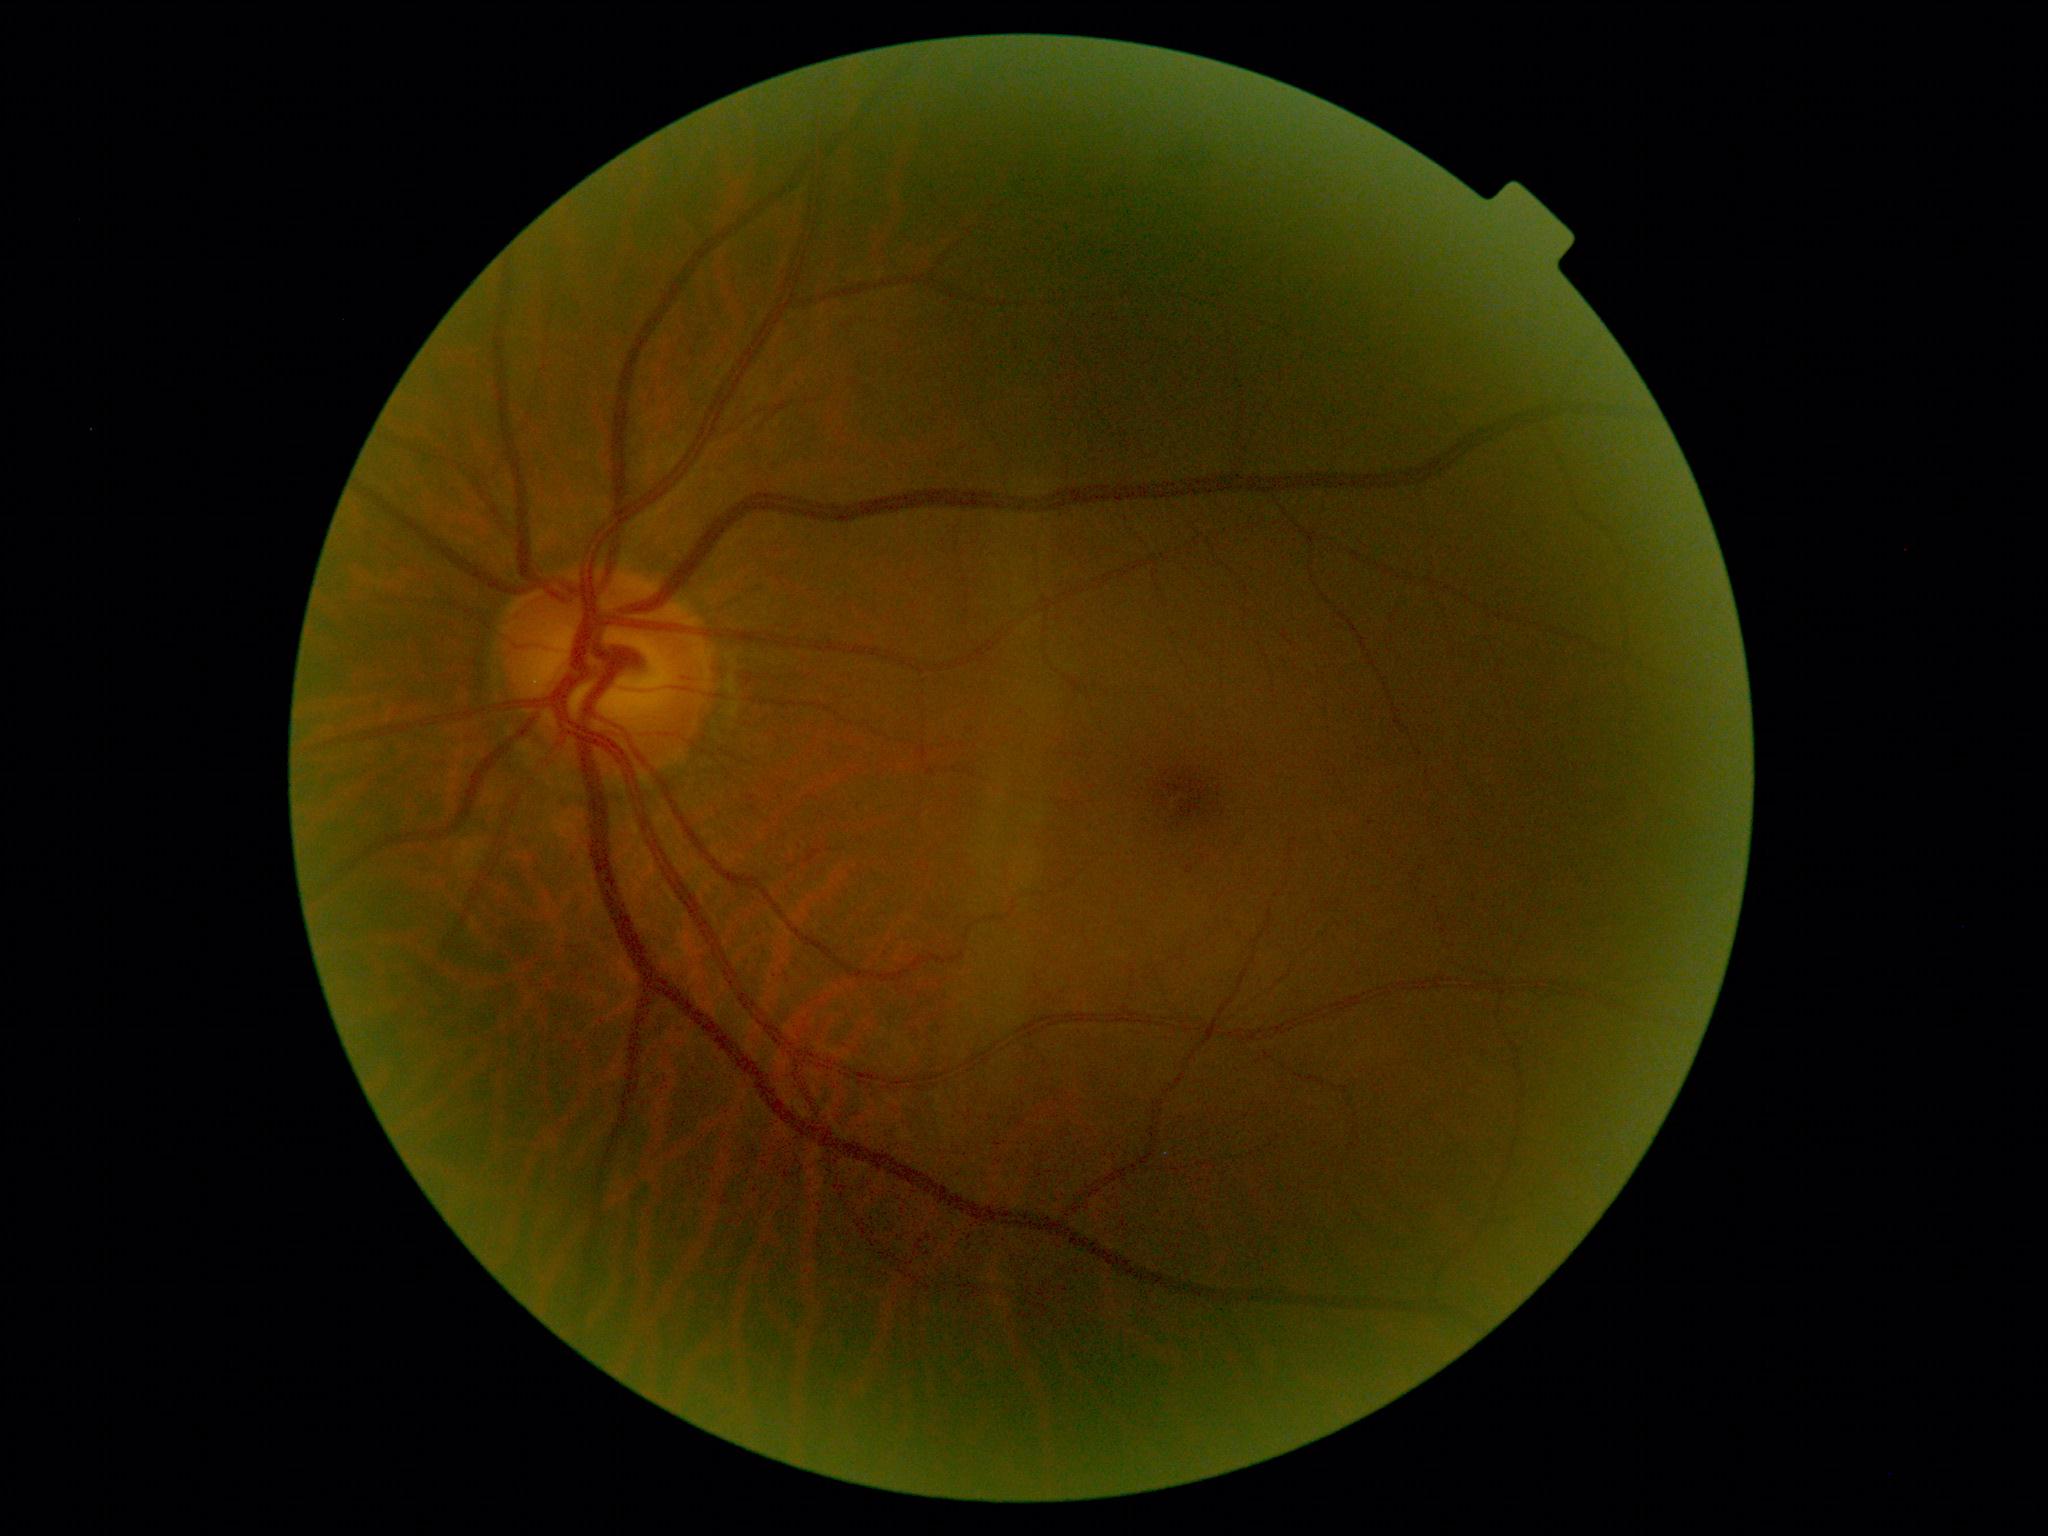

Disease class: non-proliferative diabetic retinopathy.
DR: mild non-proliferative diabetic retinopathy (grade 1).